45° FOV.
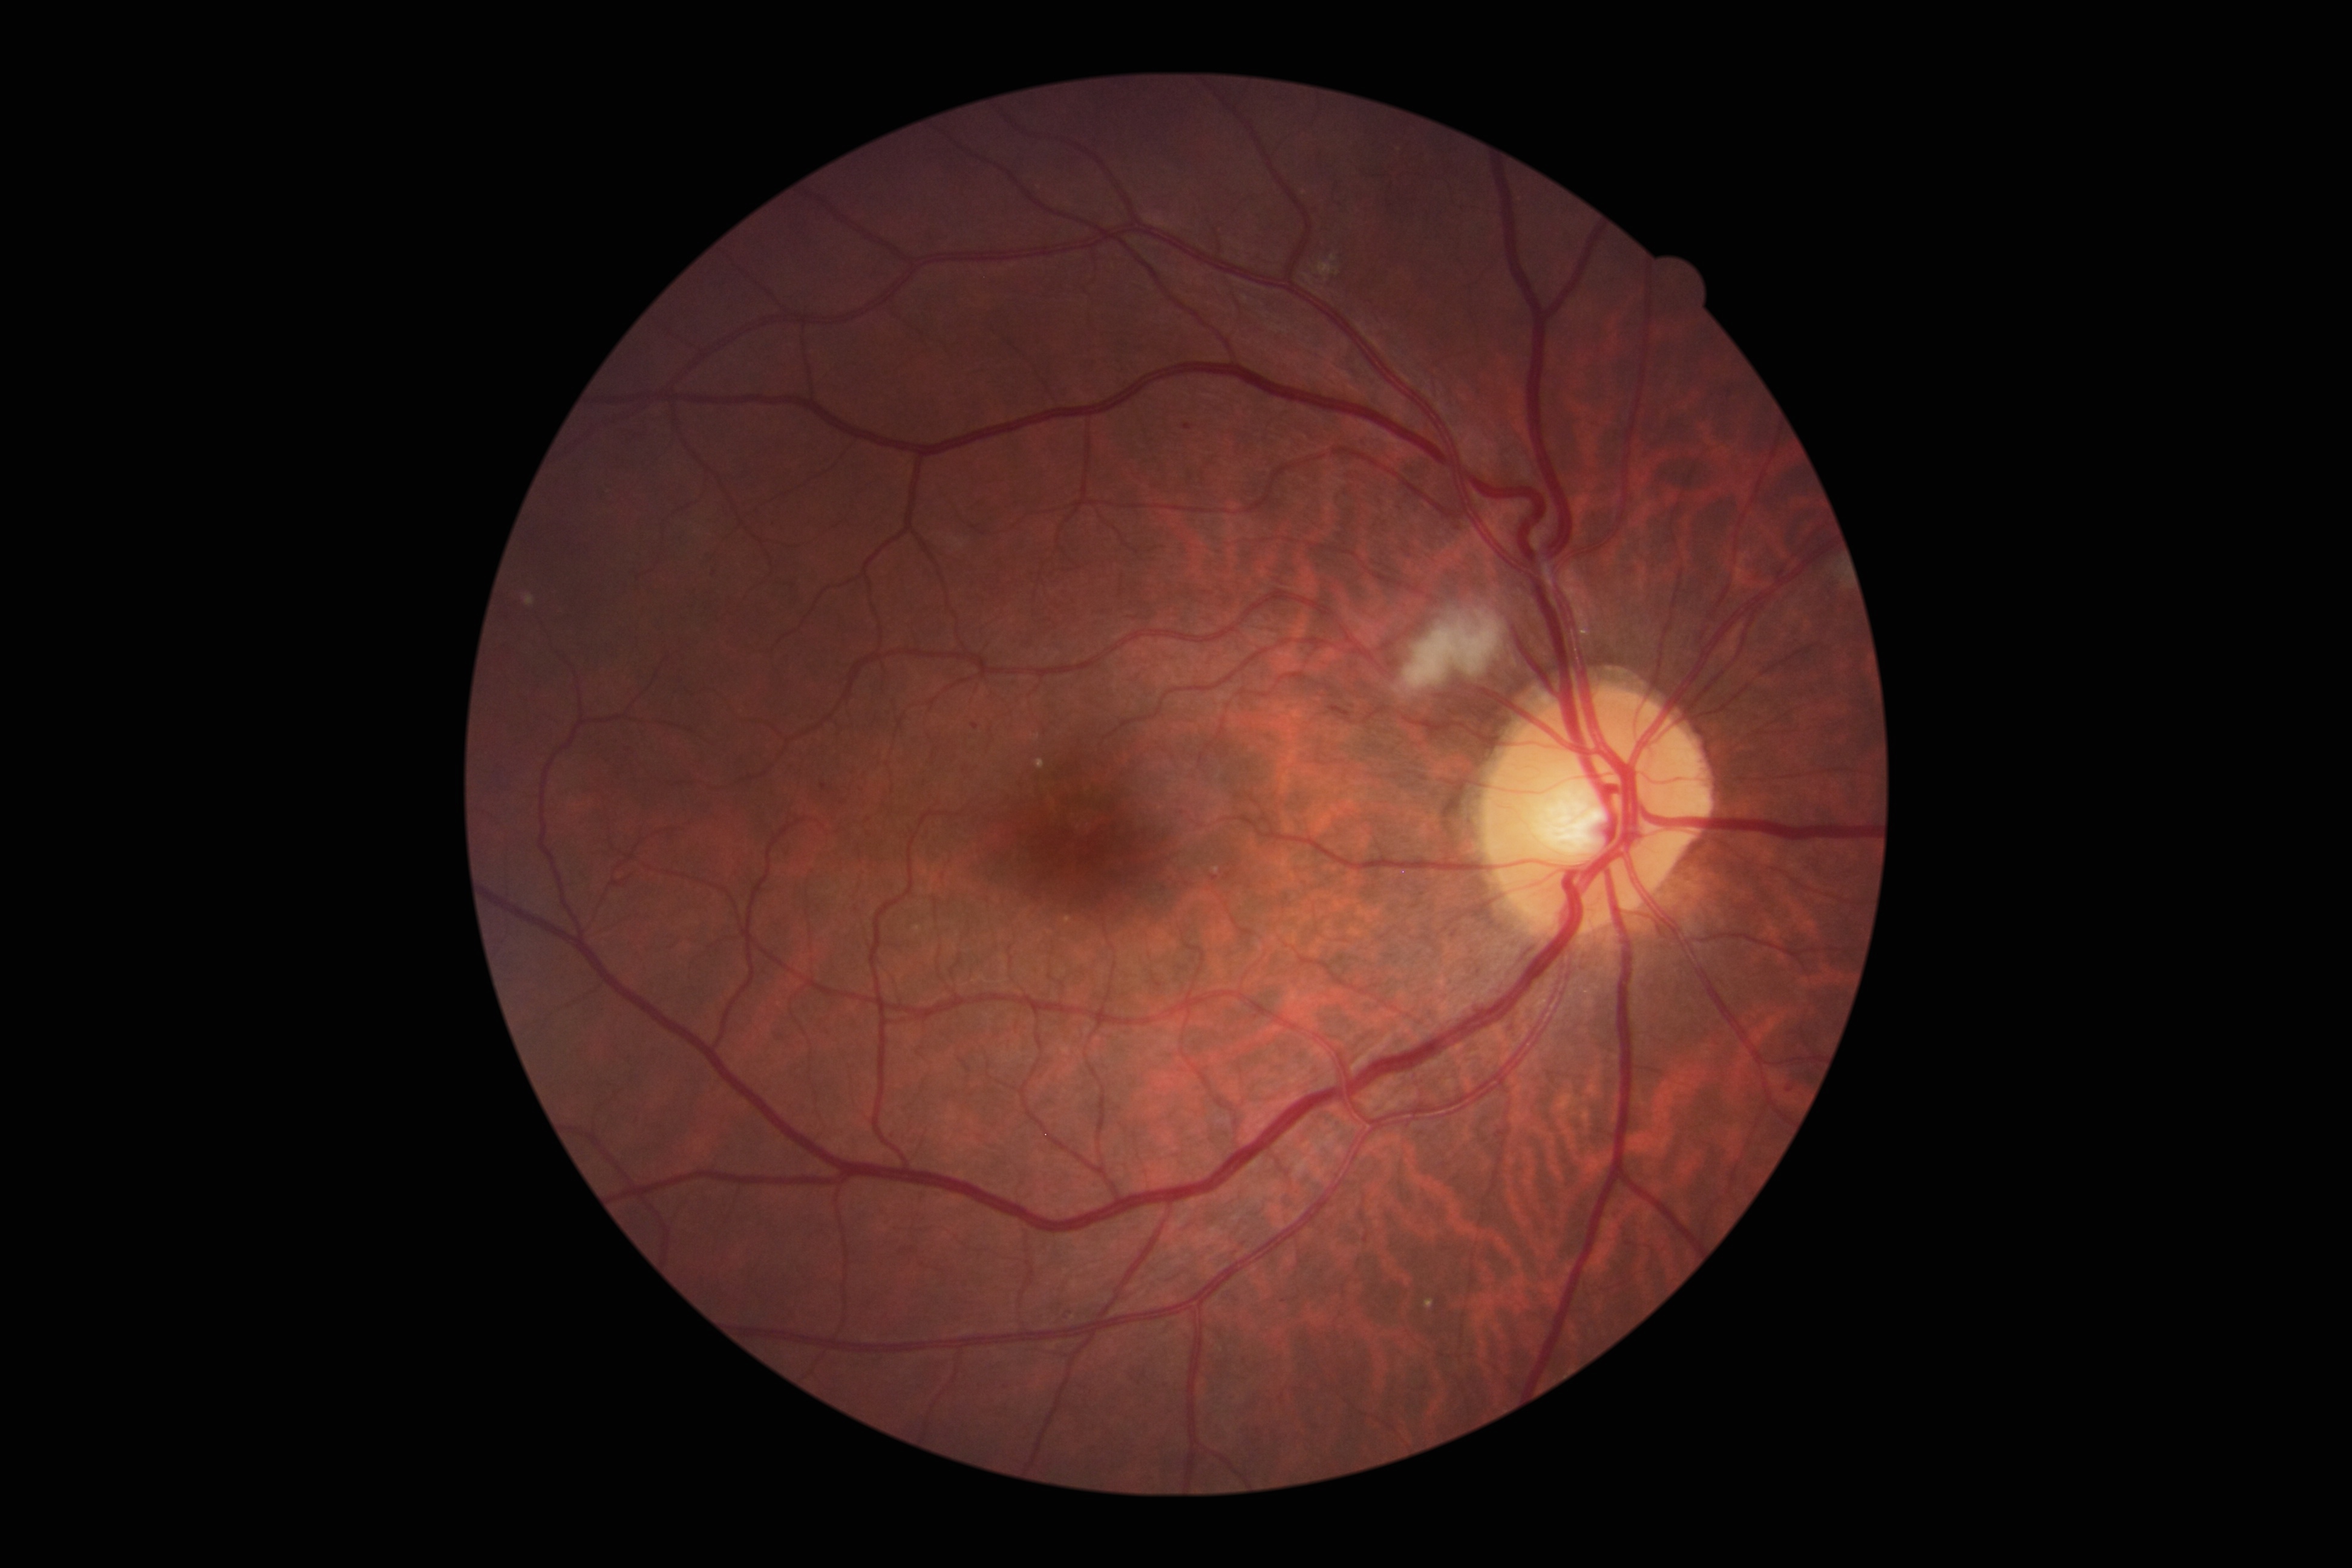 DR class: non-proliferative diabetic retinopathy
retinopathy: 2